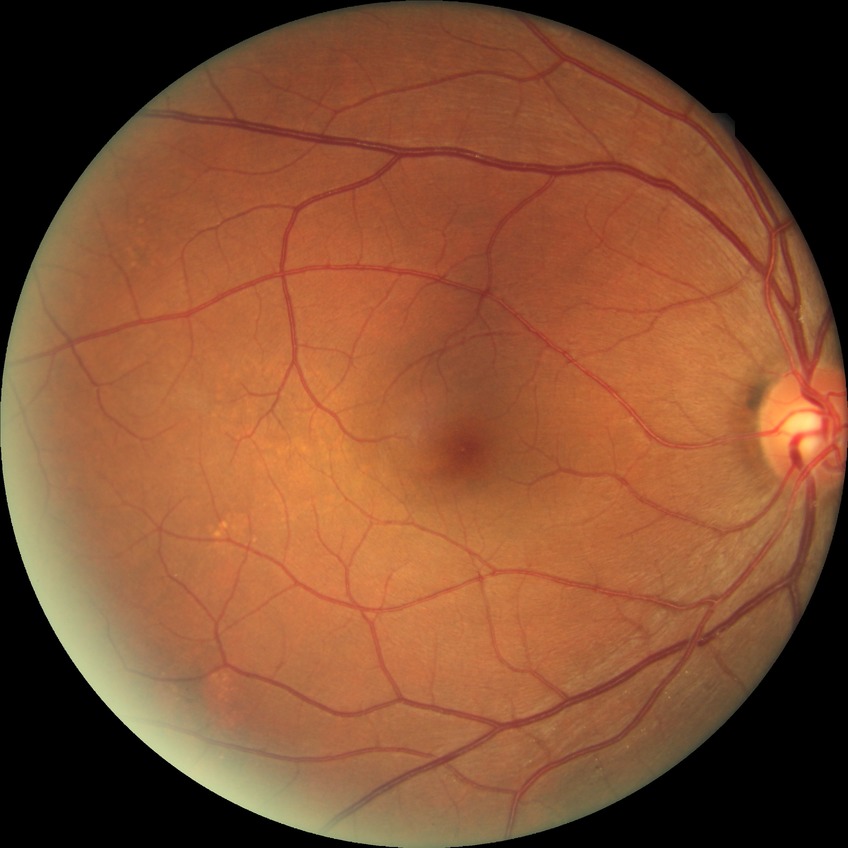 diabetic retinopathy (DR)@no diabetic retinopathy (NDR).